No pharmacologic dilation; 848 by 848 pixels.
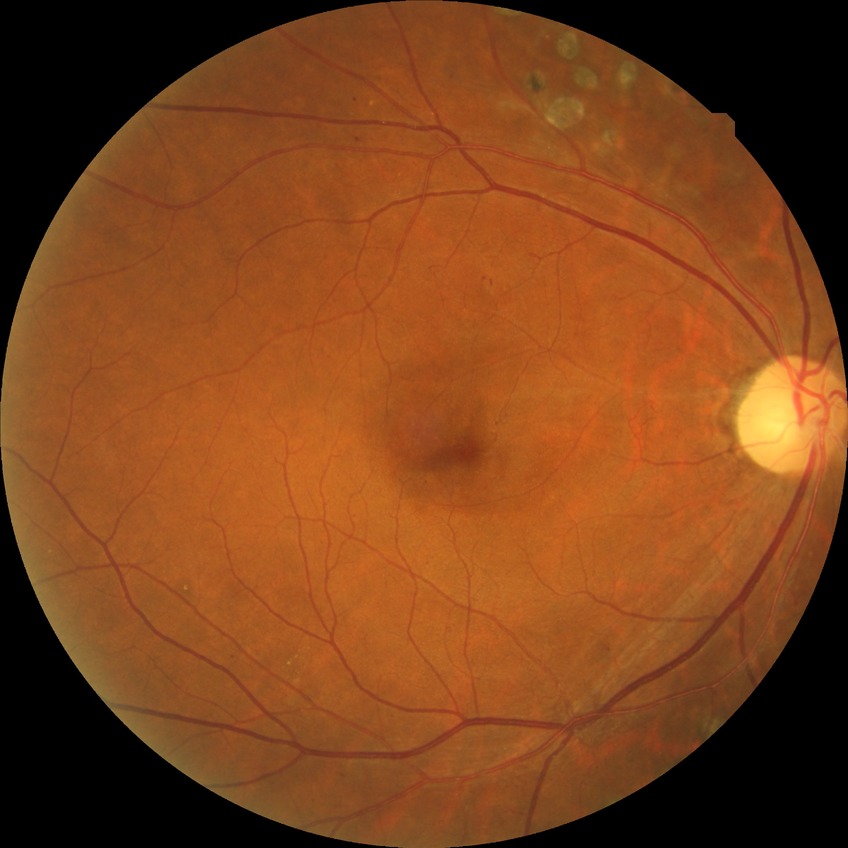

diabetic retinopathy (DR): PPDR (pre-proliferative diabetic retinopathy), DR class: non-proliferative diabetic retinopathy.